Without pupil dilation:
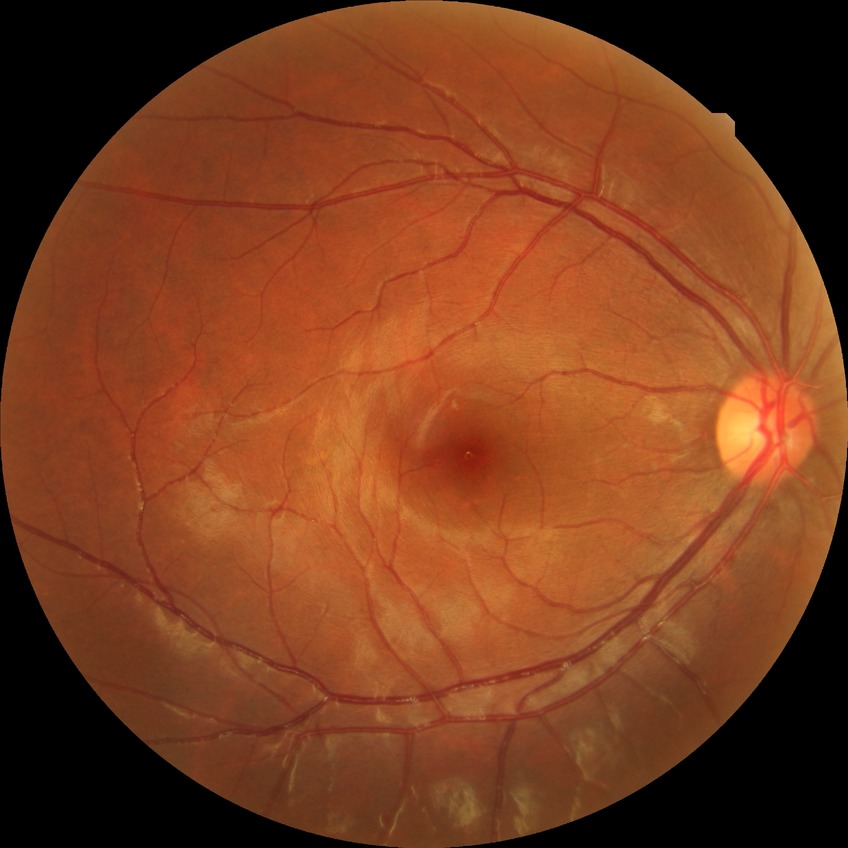
DR stage = NDR; DR impression = no apparent DR.